Retinal fundus photograph; captured on a Bosch handheld fundus camera:
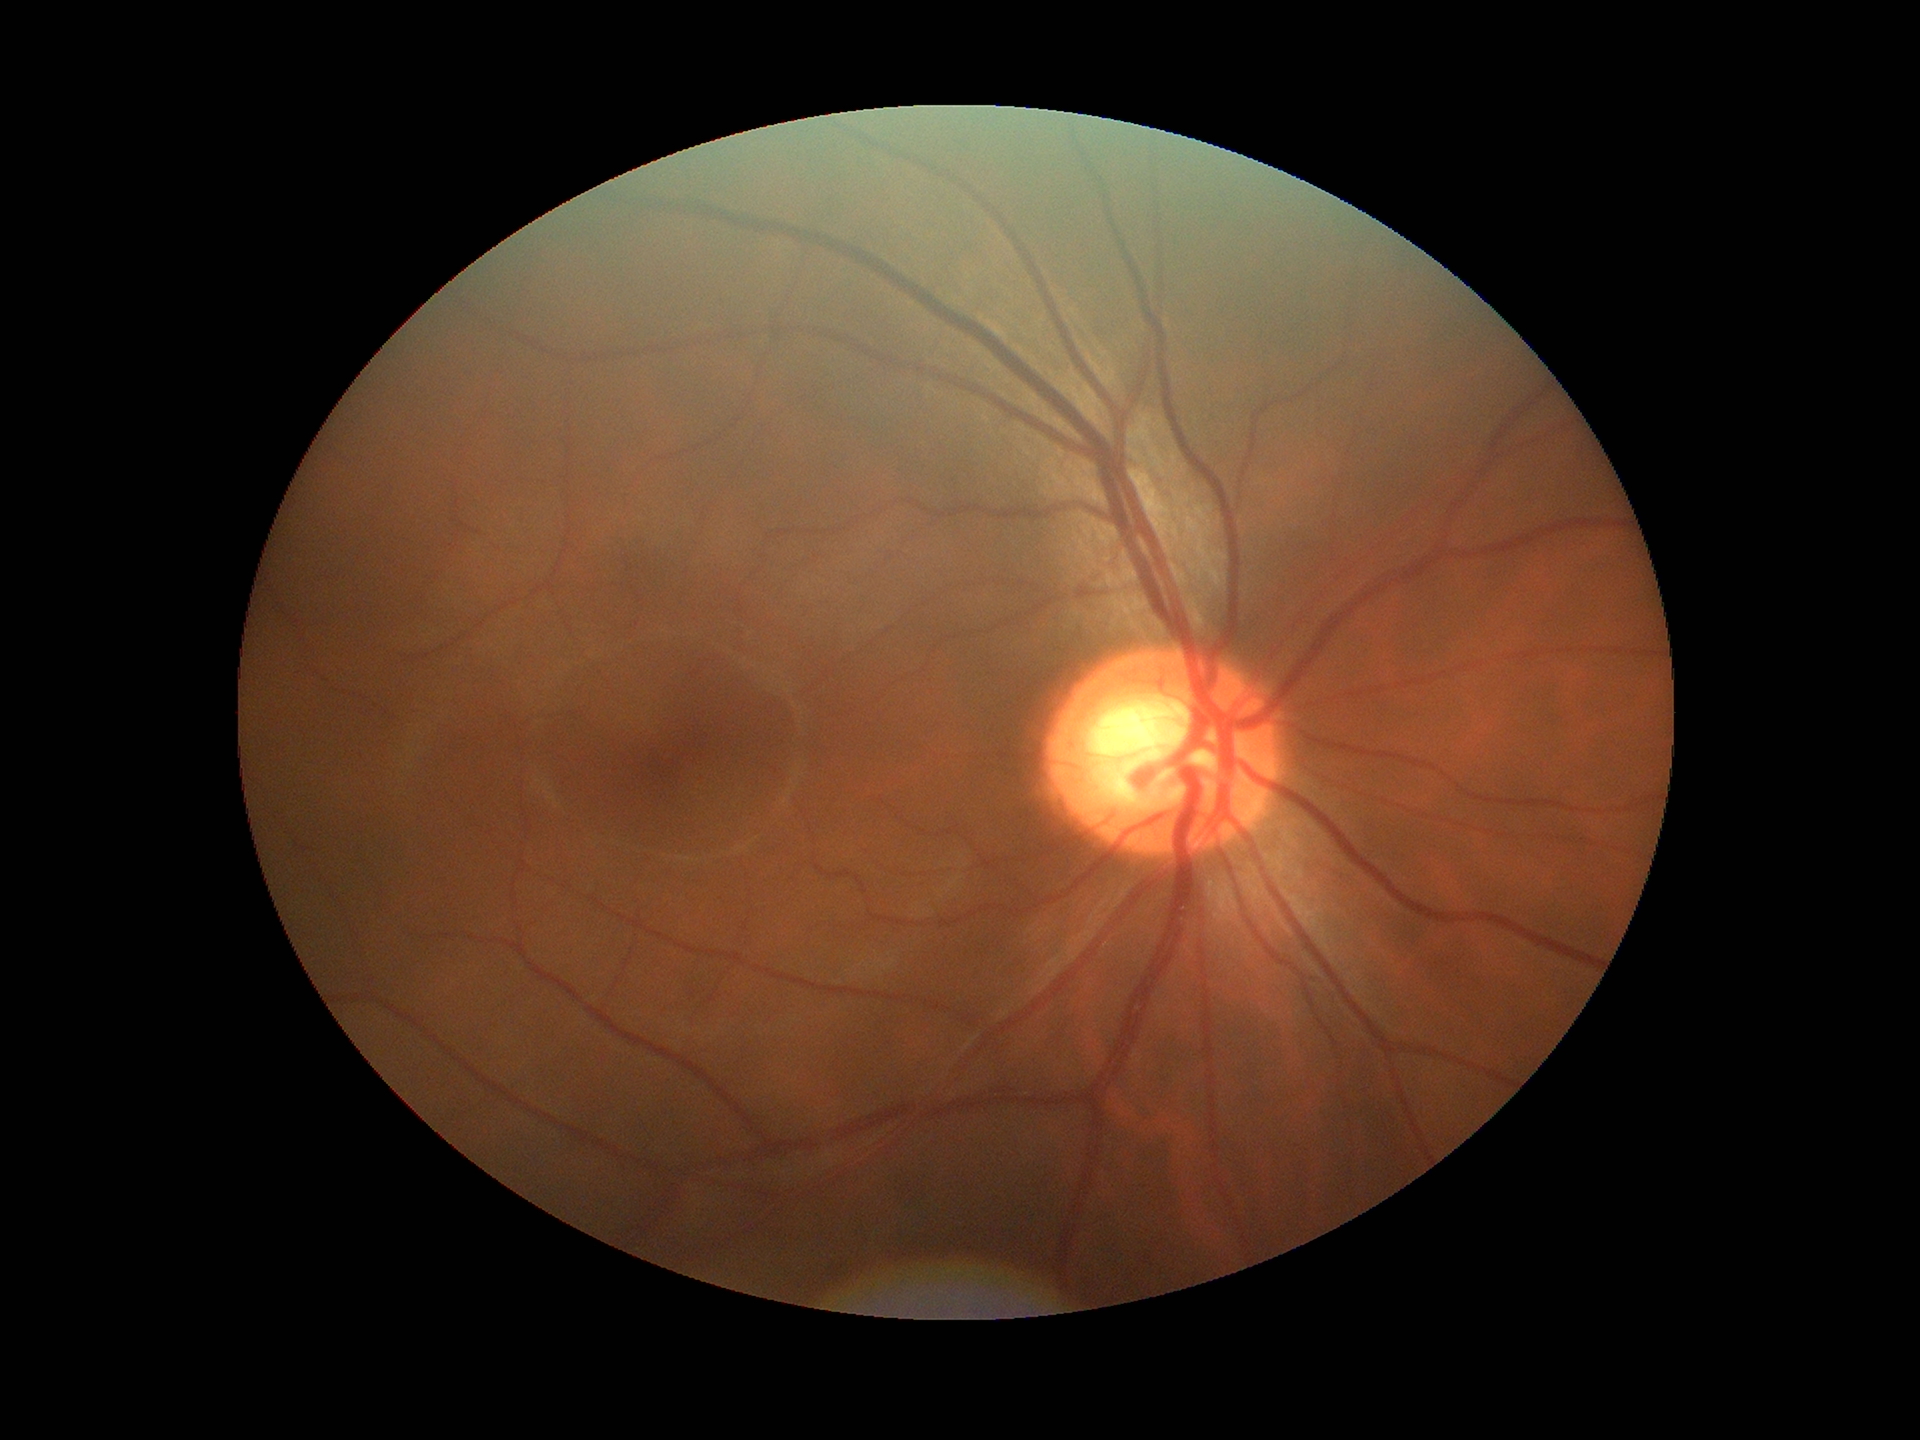
{"glaucoma_decision": "suspect", "vcdr": "0.65", "acdr": "0.41"}